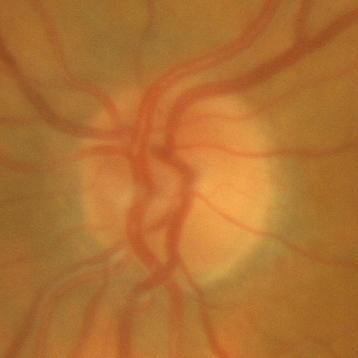

No glaucoma.